1240 by 1240 pixels; wide-field fundus photograph of an infant:
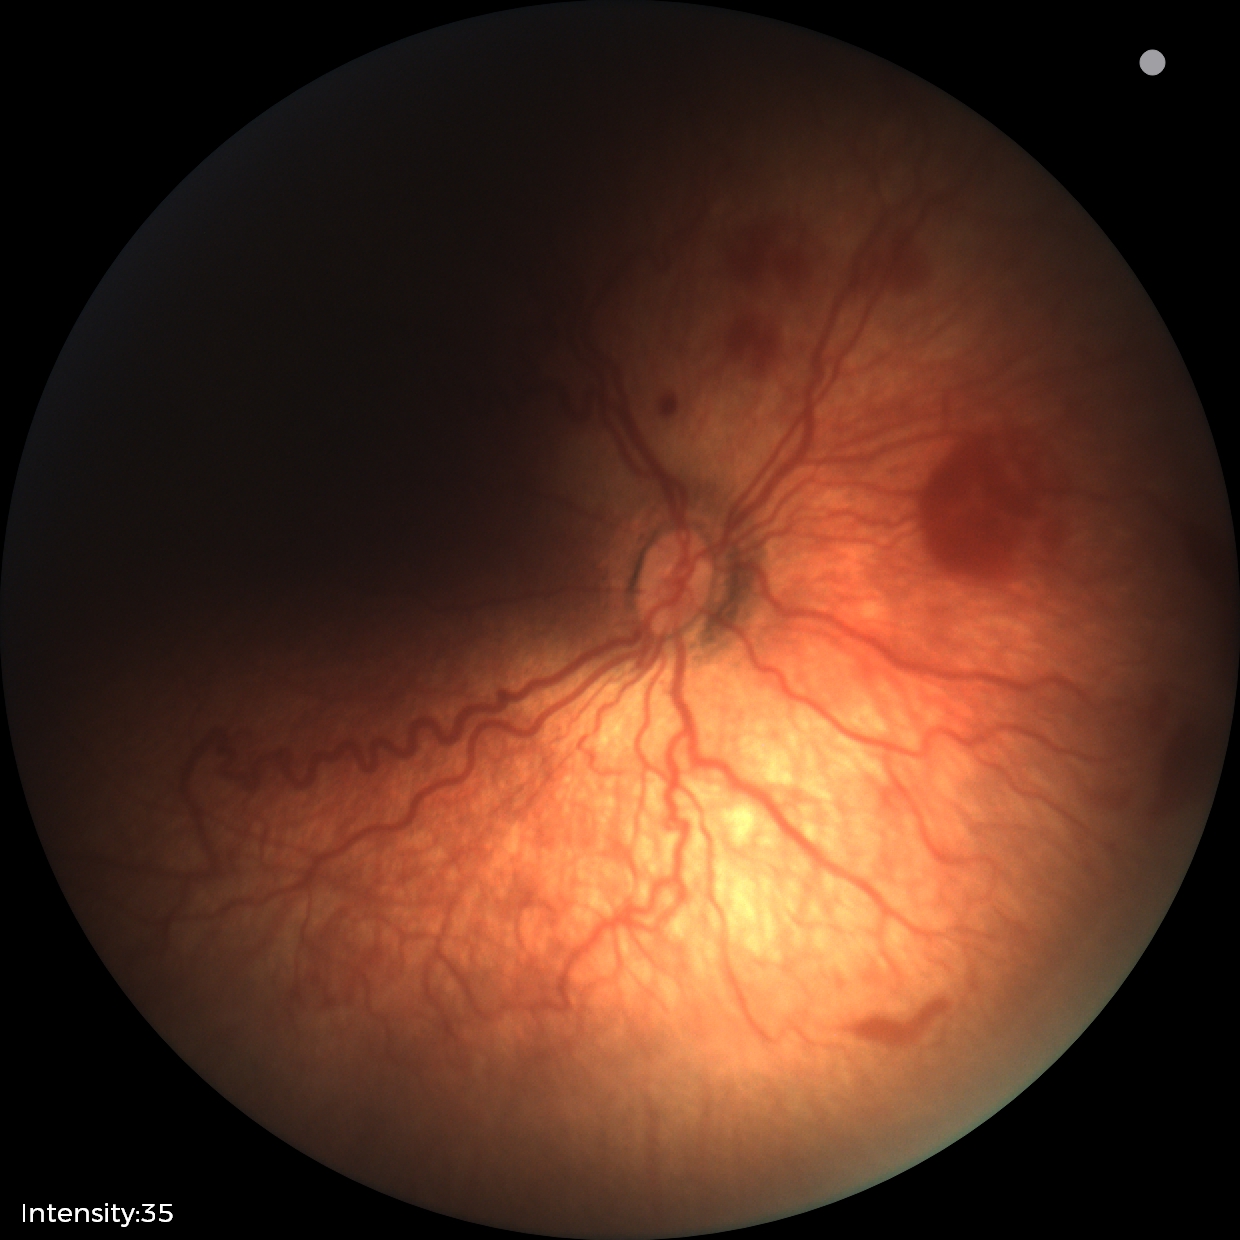
Screening series with retinopathy of prematurity stage 2.